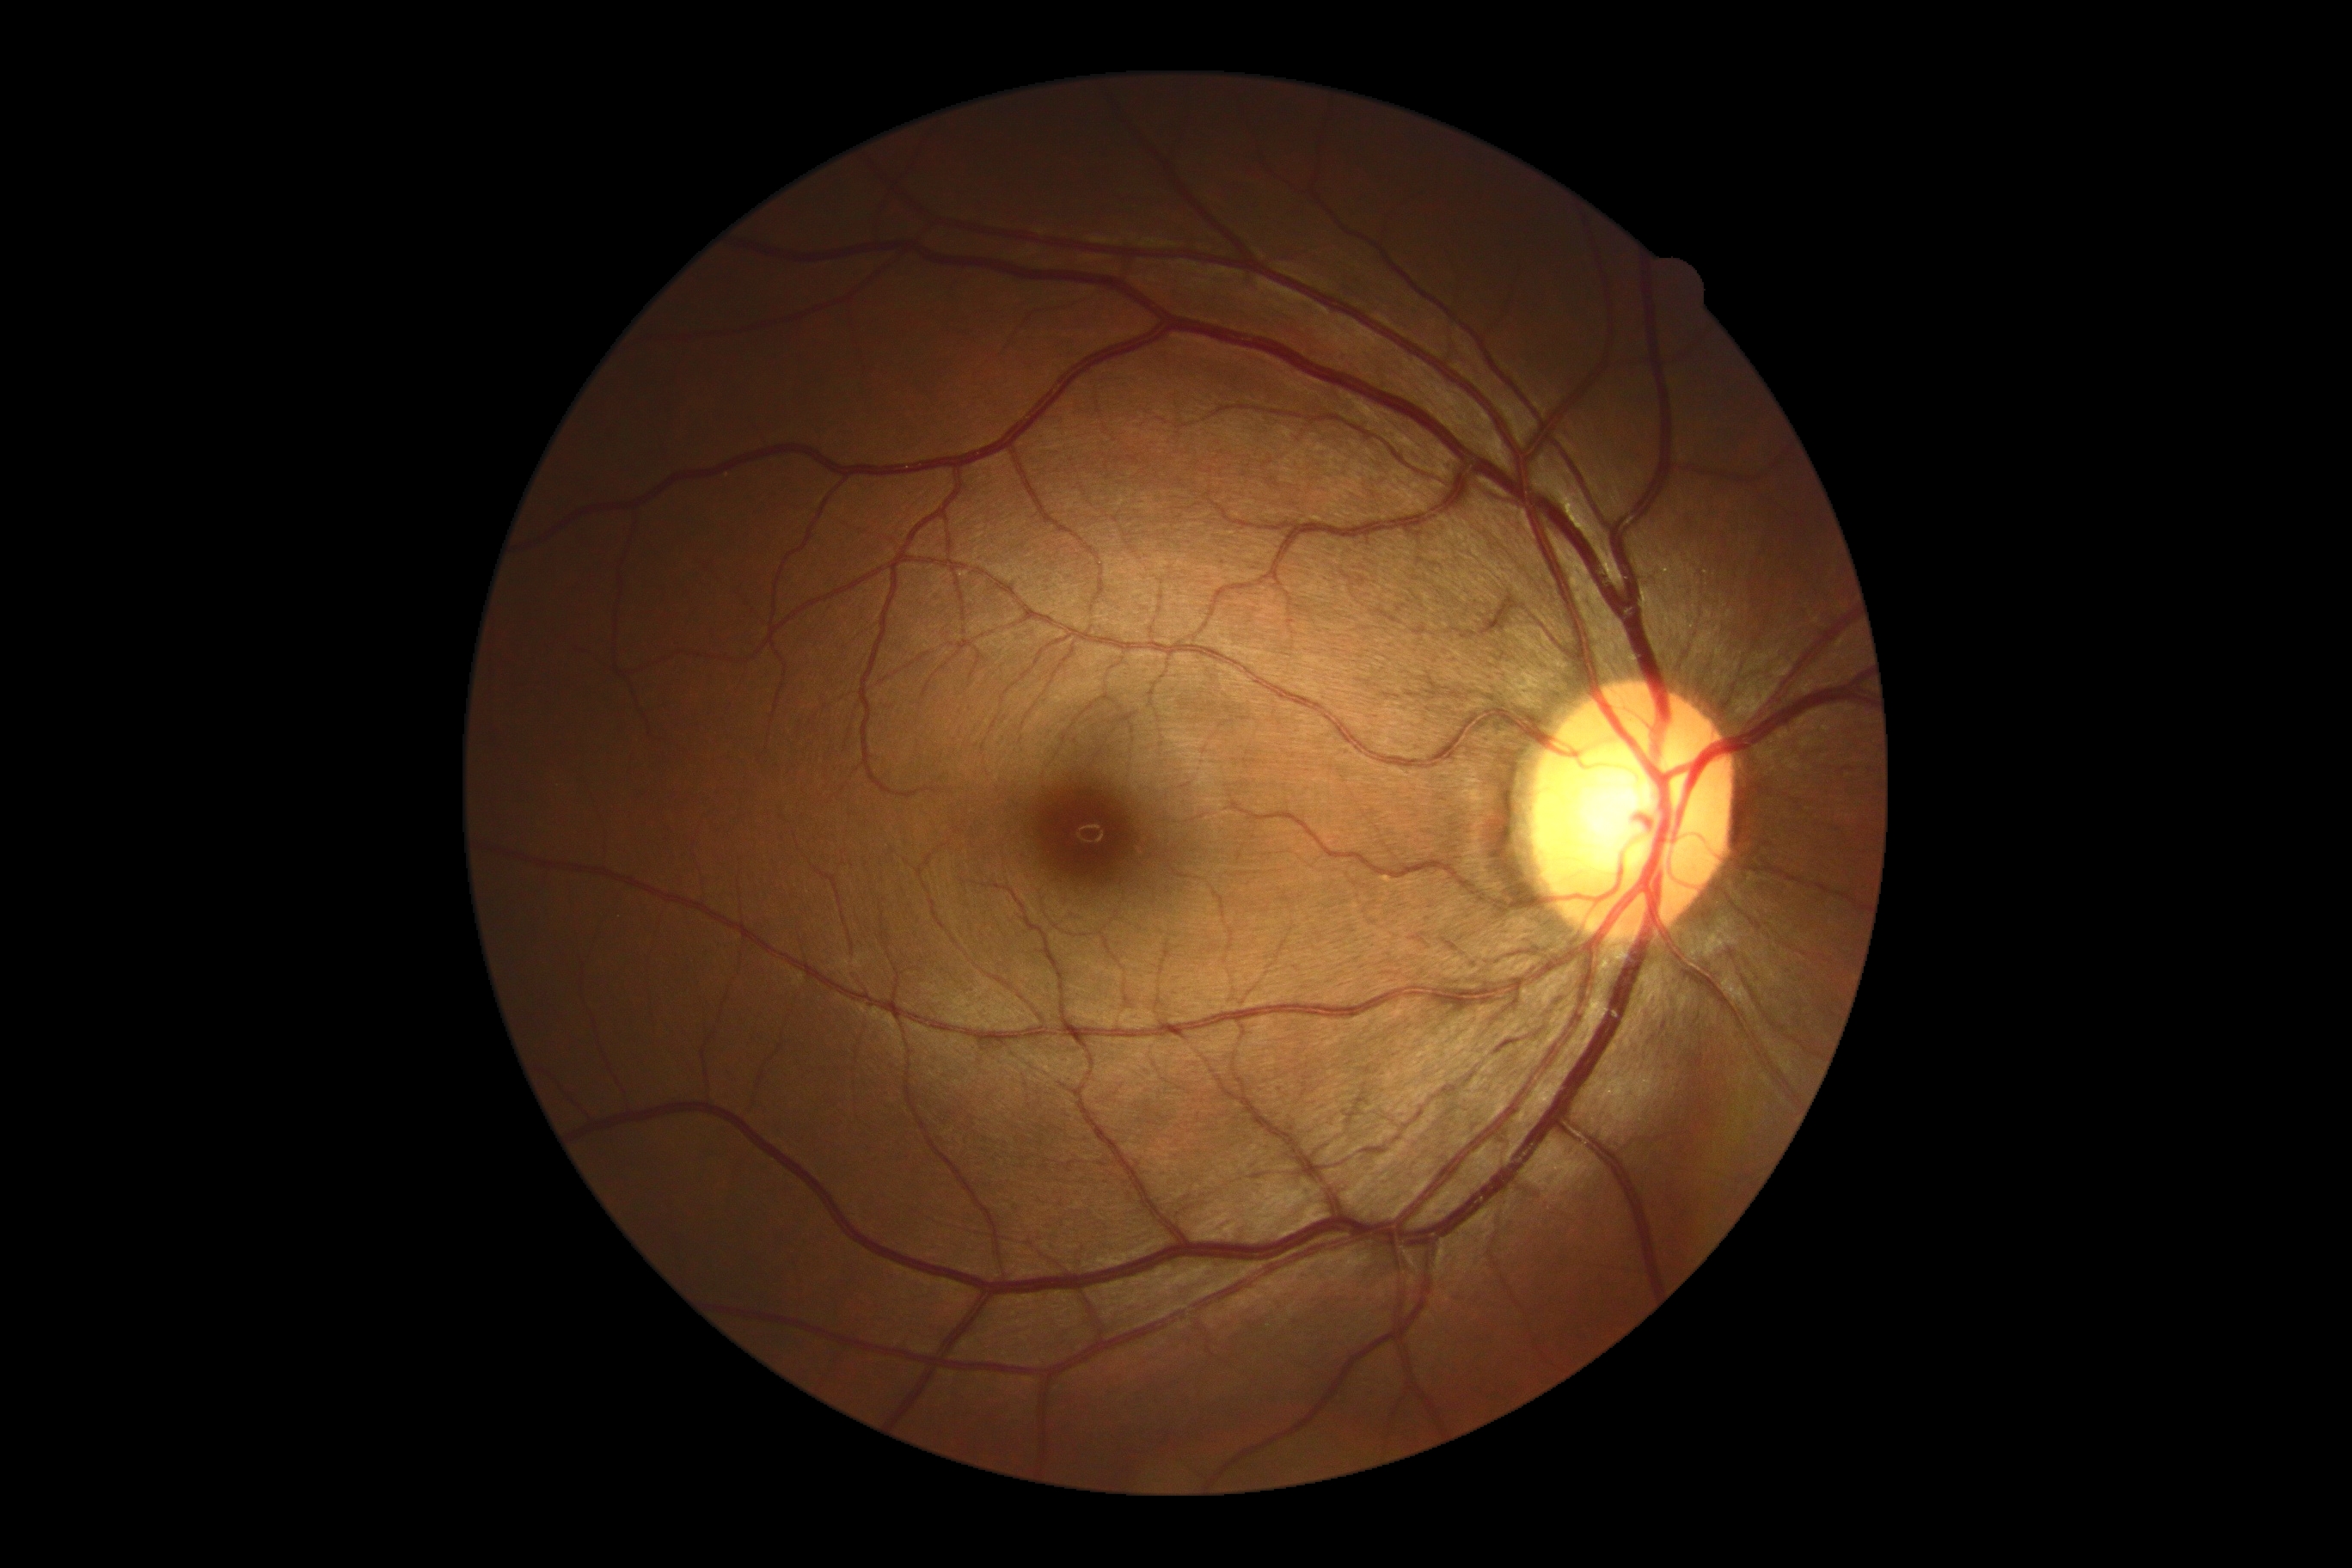
retinopathy=no apparent retinopathy (grade 0).